CFP, 45-degree field of view
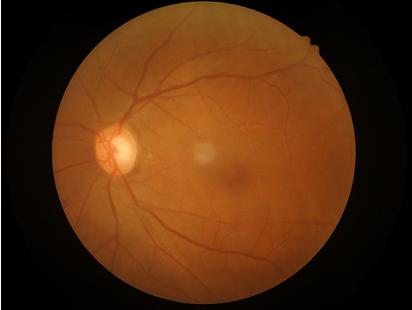 Good dynamic range. Overall quality is good and the image is gradable. Illumination is even. The image is clear.